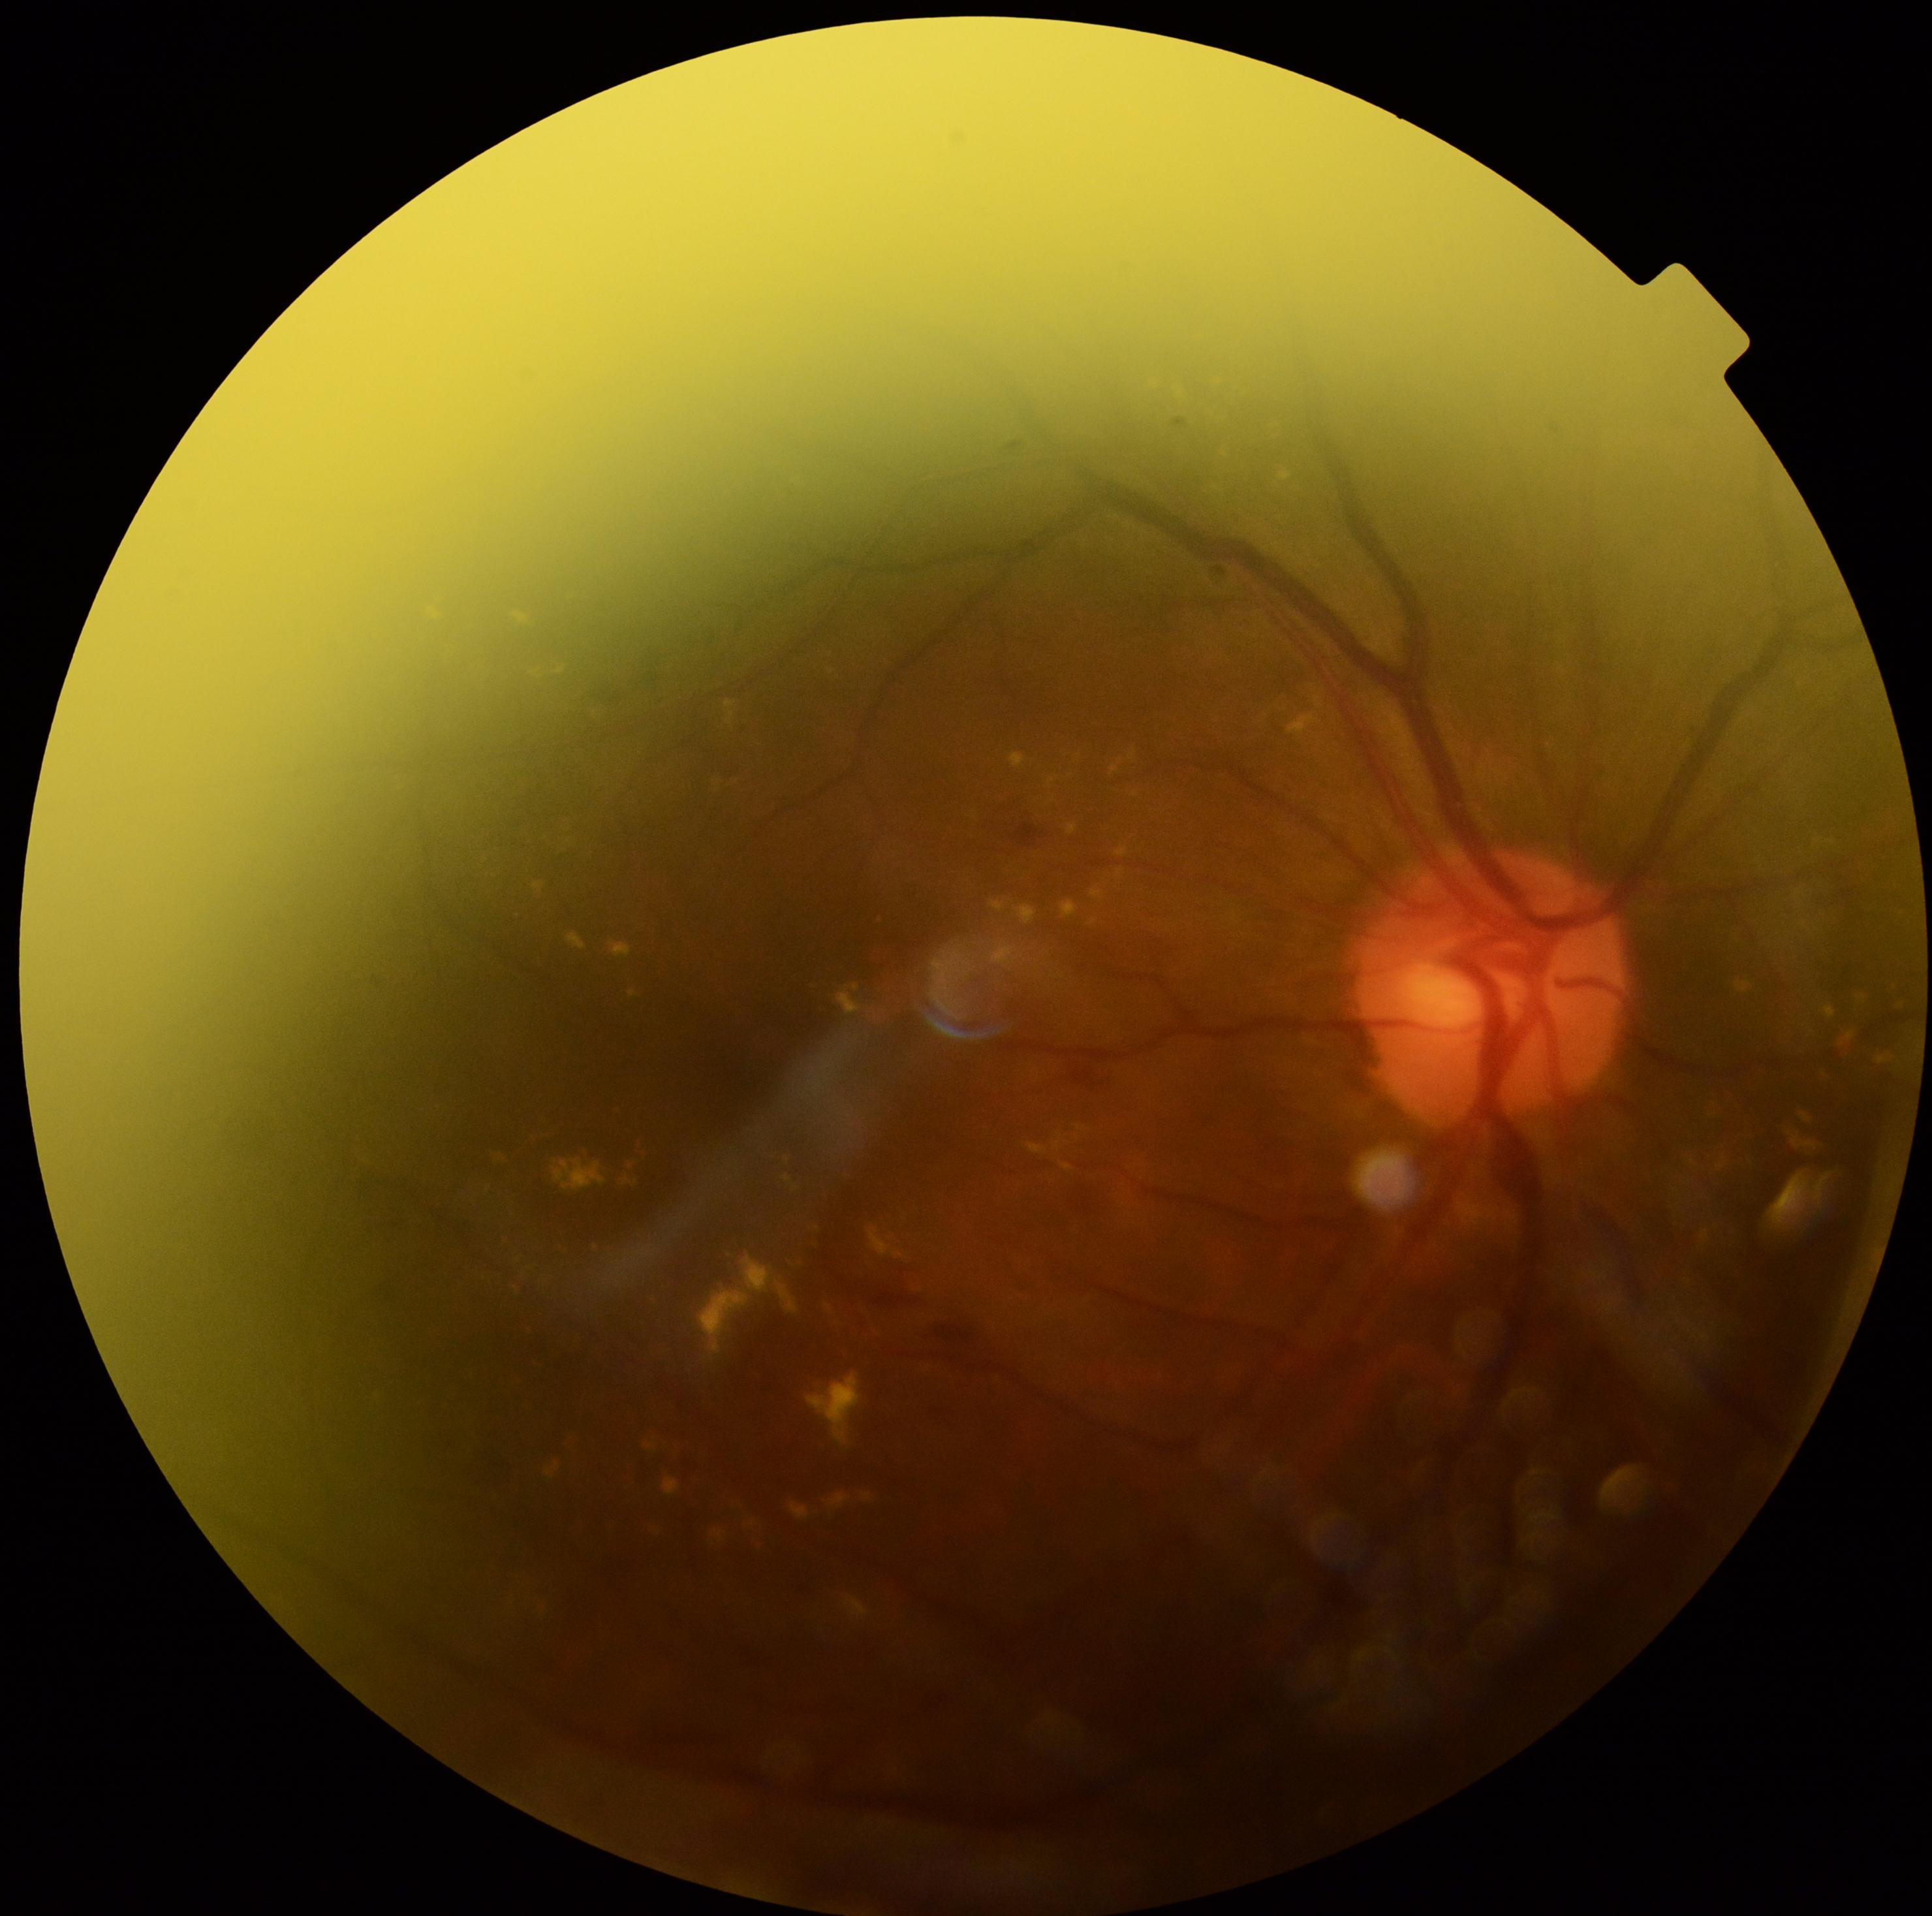
Diabetic retinopathy (DR): 2/4. Disease class: non-proliferative diabetic retinopathy.